Color fundus photograph, 2352x1568px
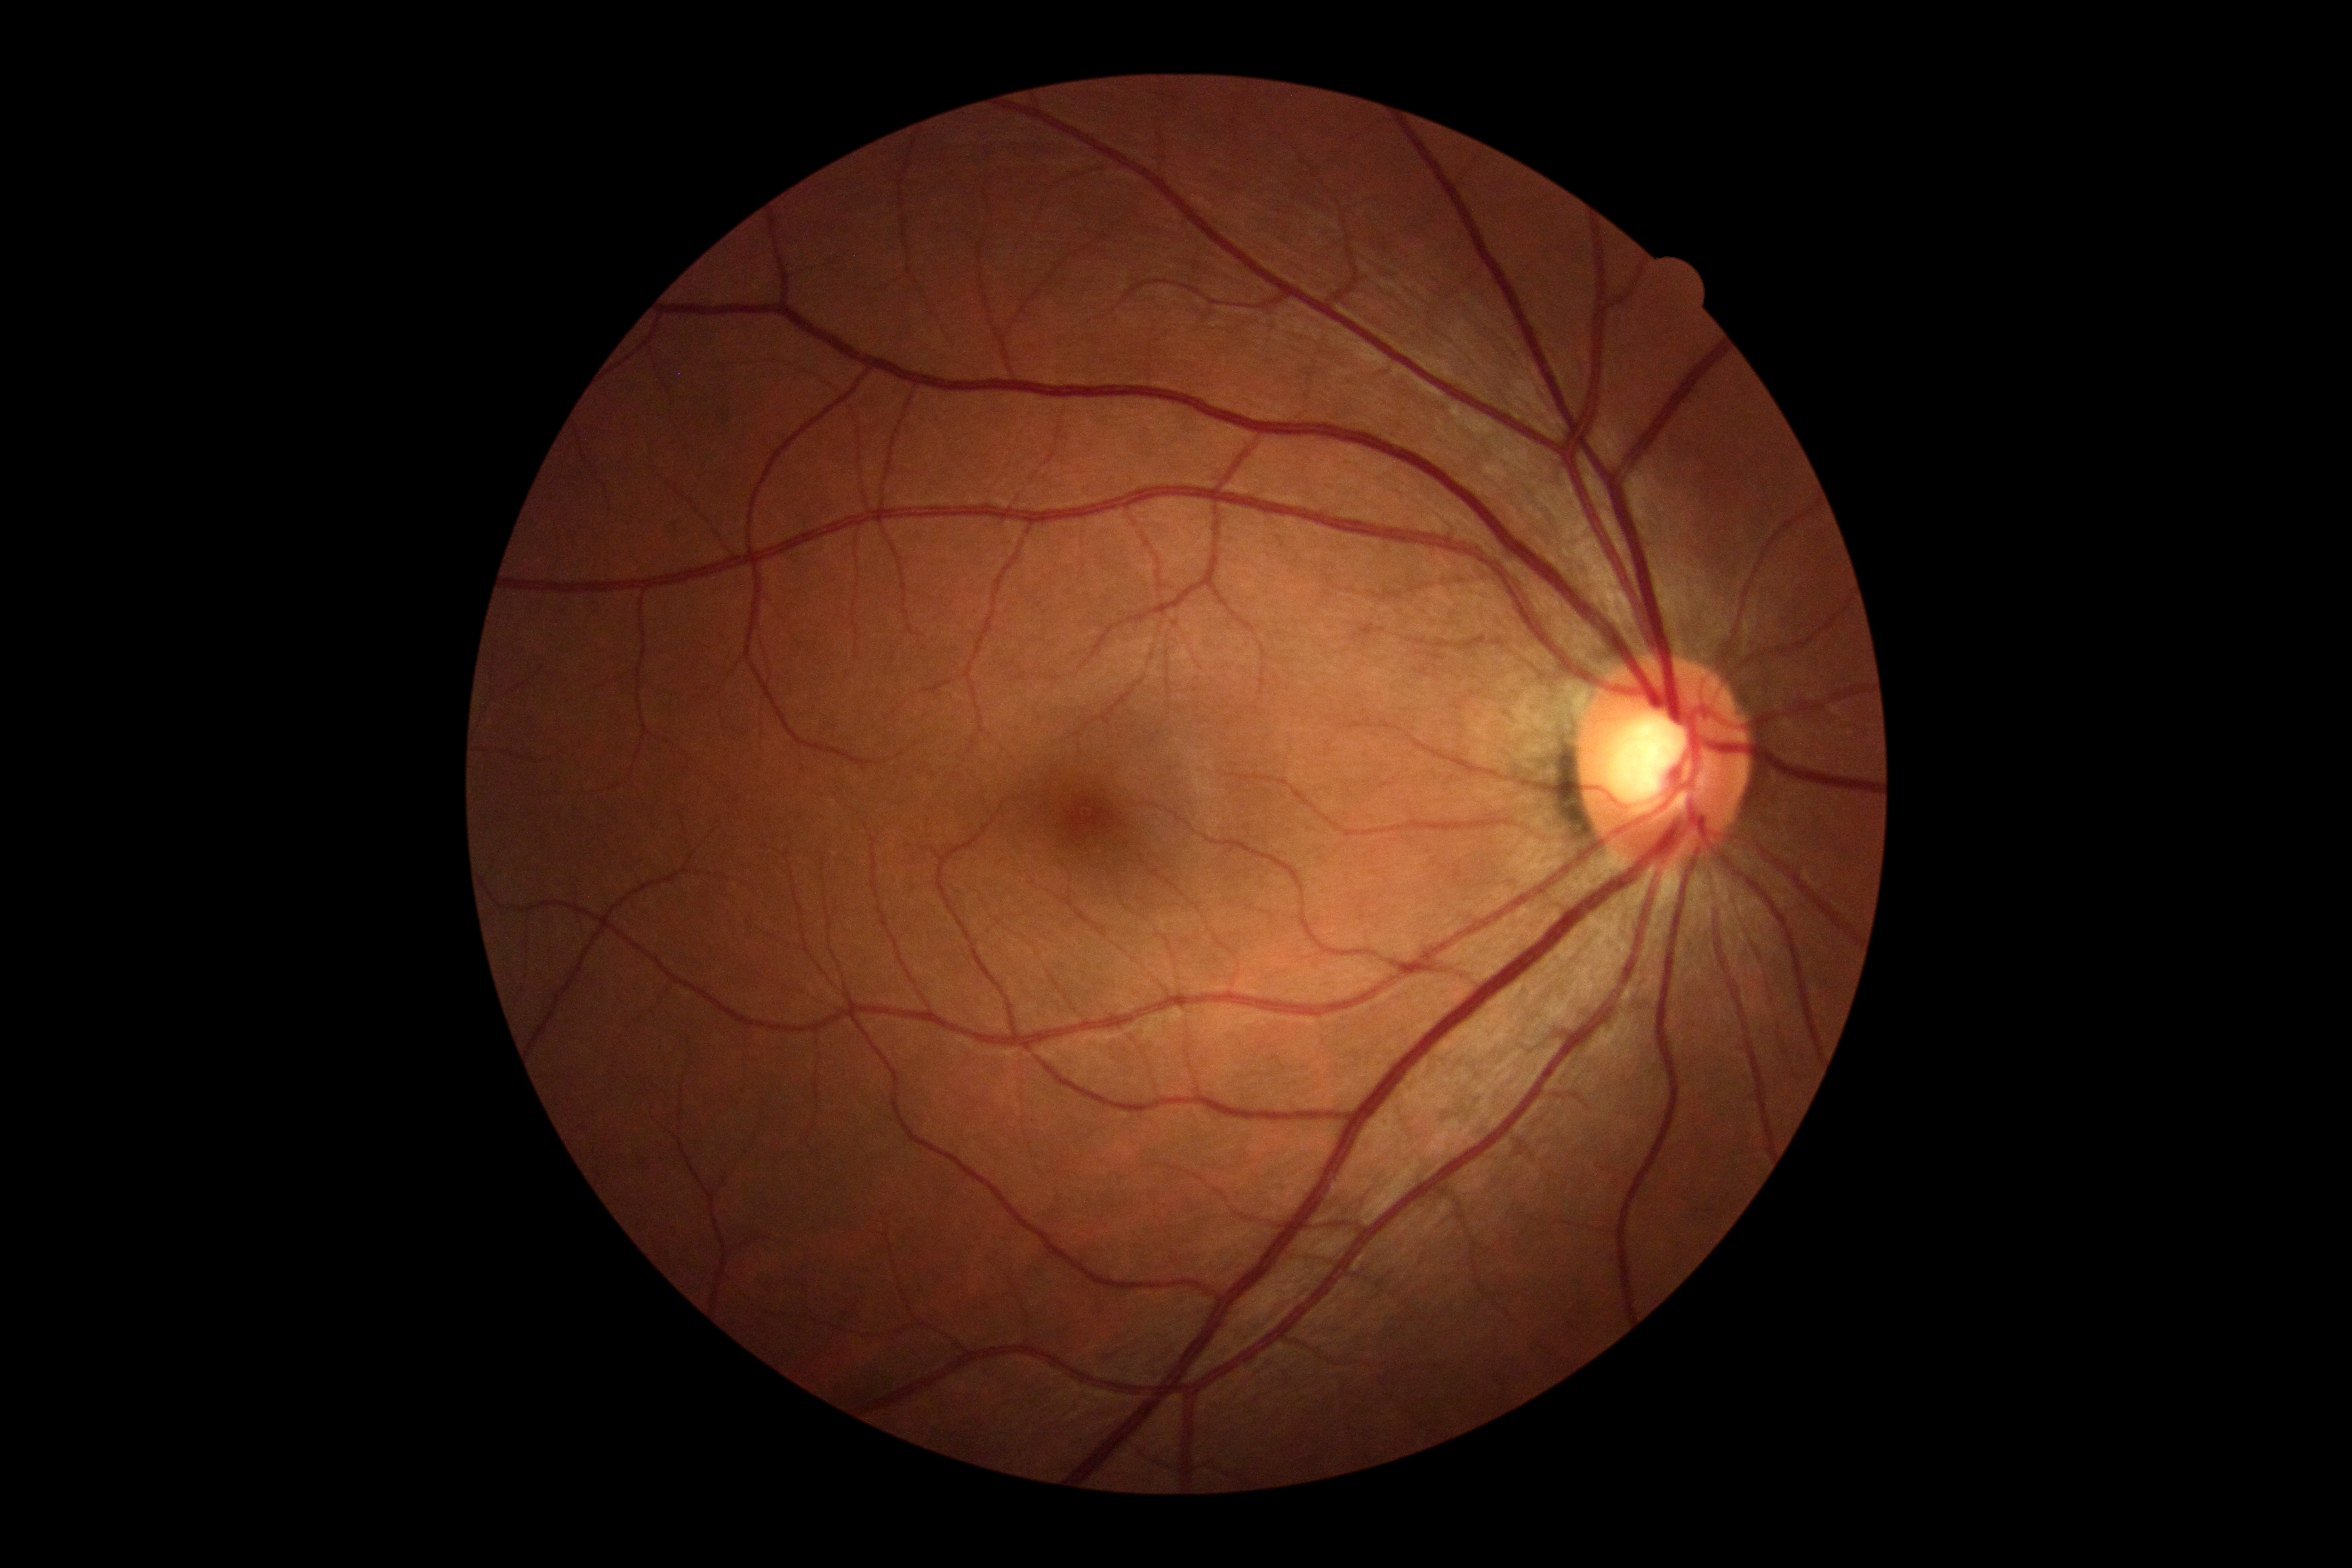

Diabetic retinopathy grade is 0/4.